Wide-field fundus photograph of an infant · 1240x1240px — 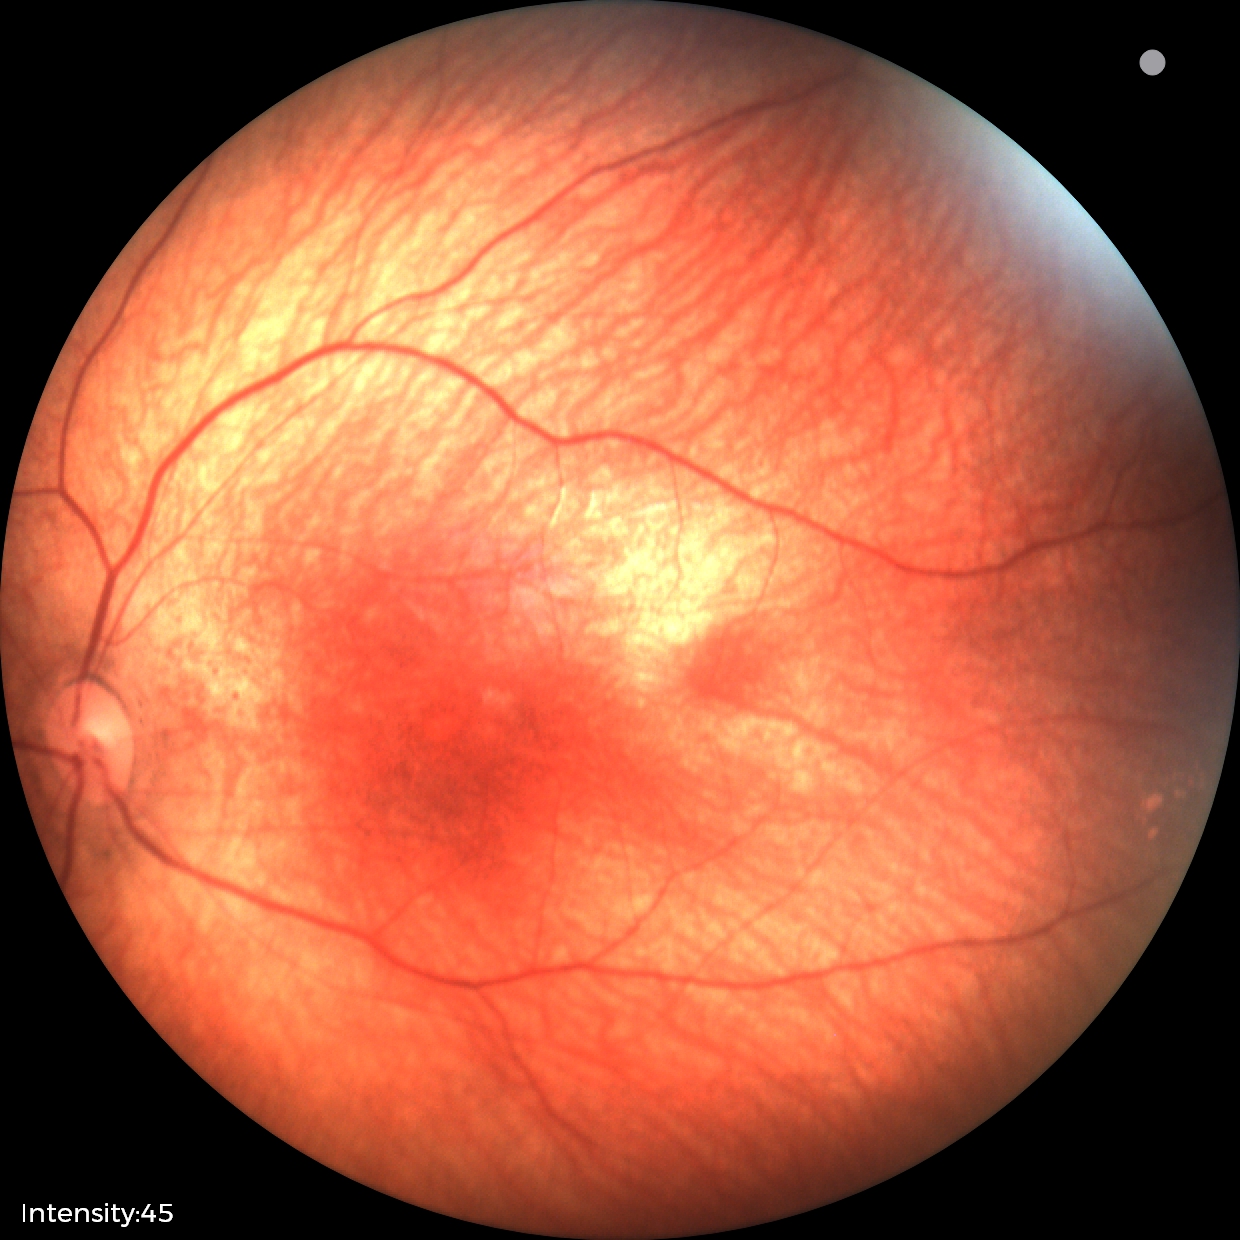

Examination with physiological retinal findings.